2352x1568; 45-degree field of view; retinal fundus photograph.
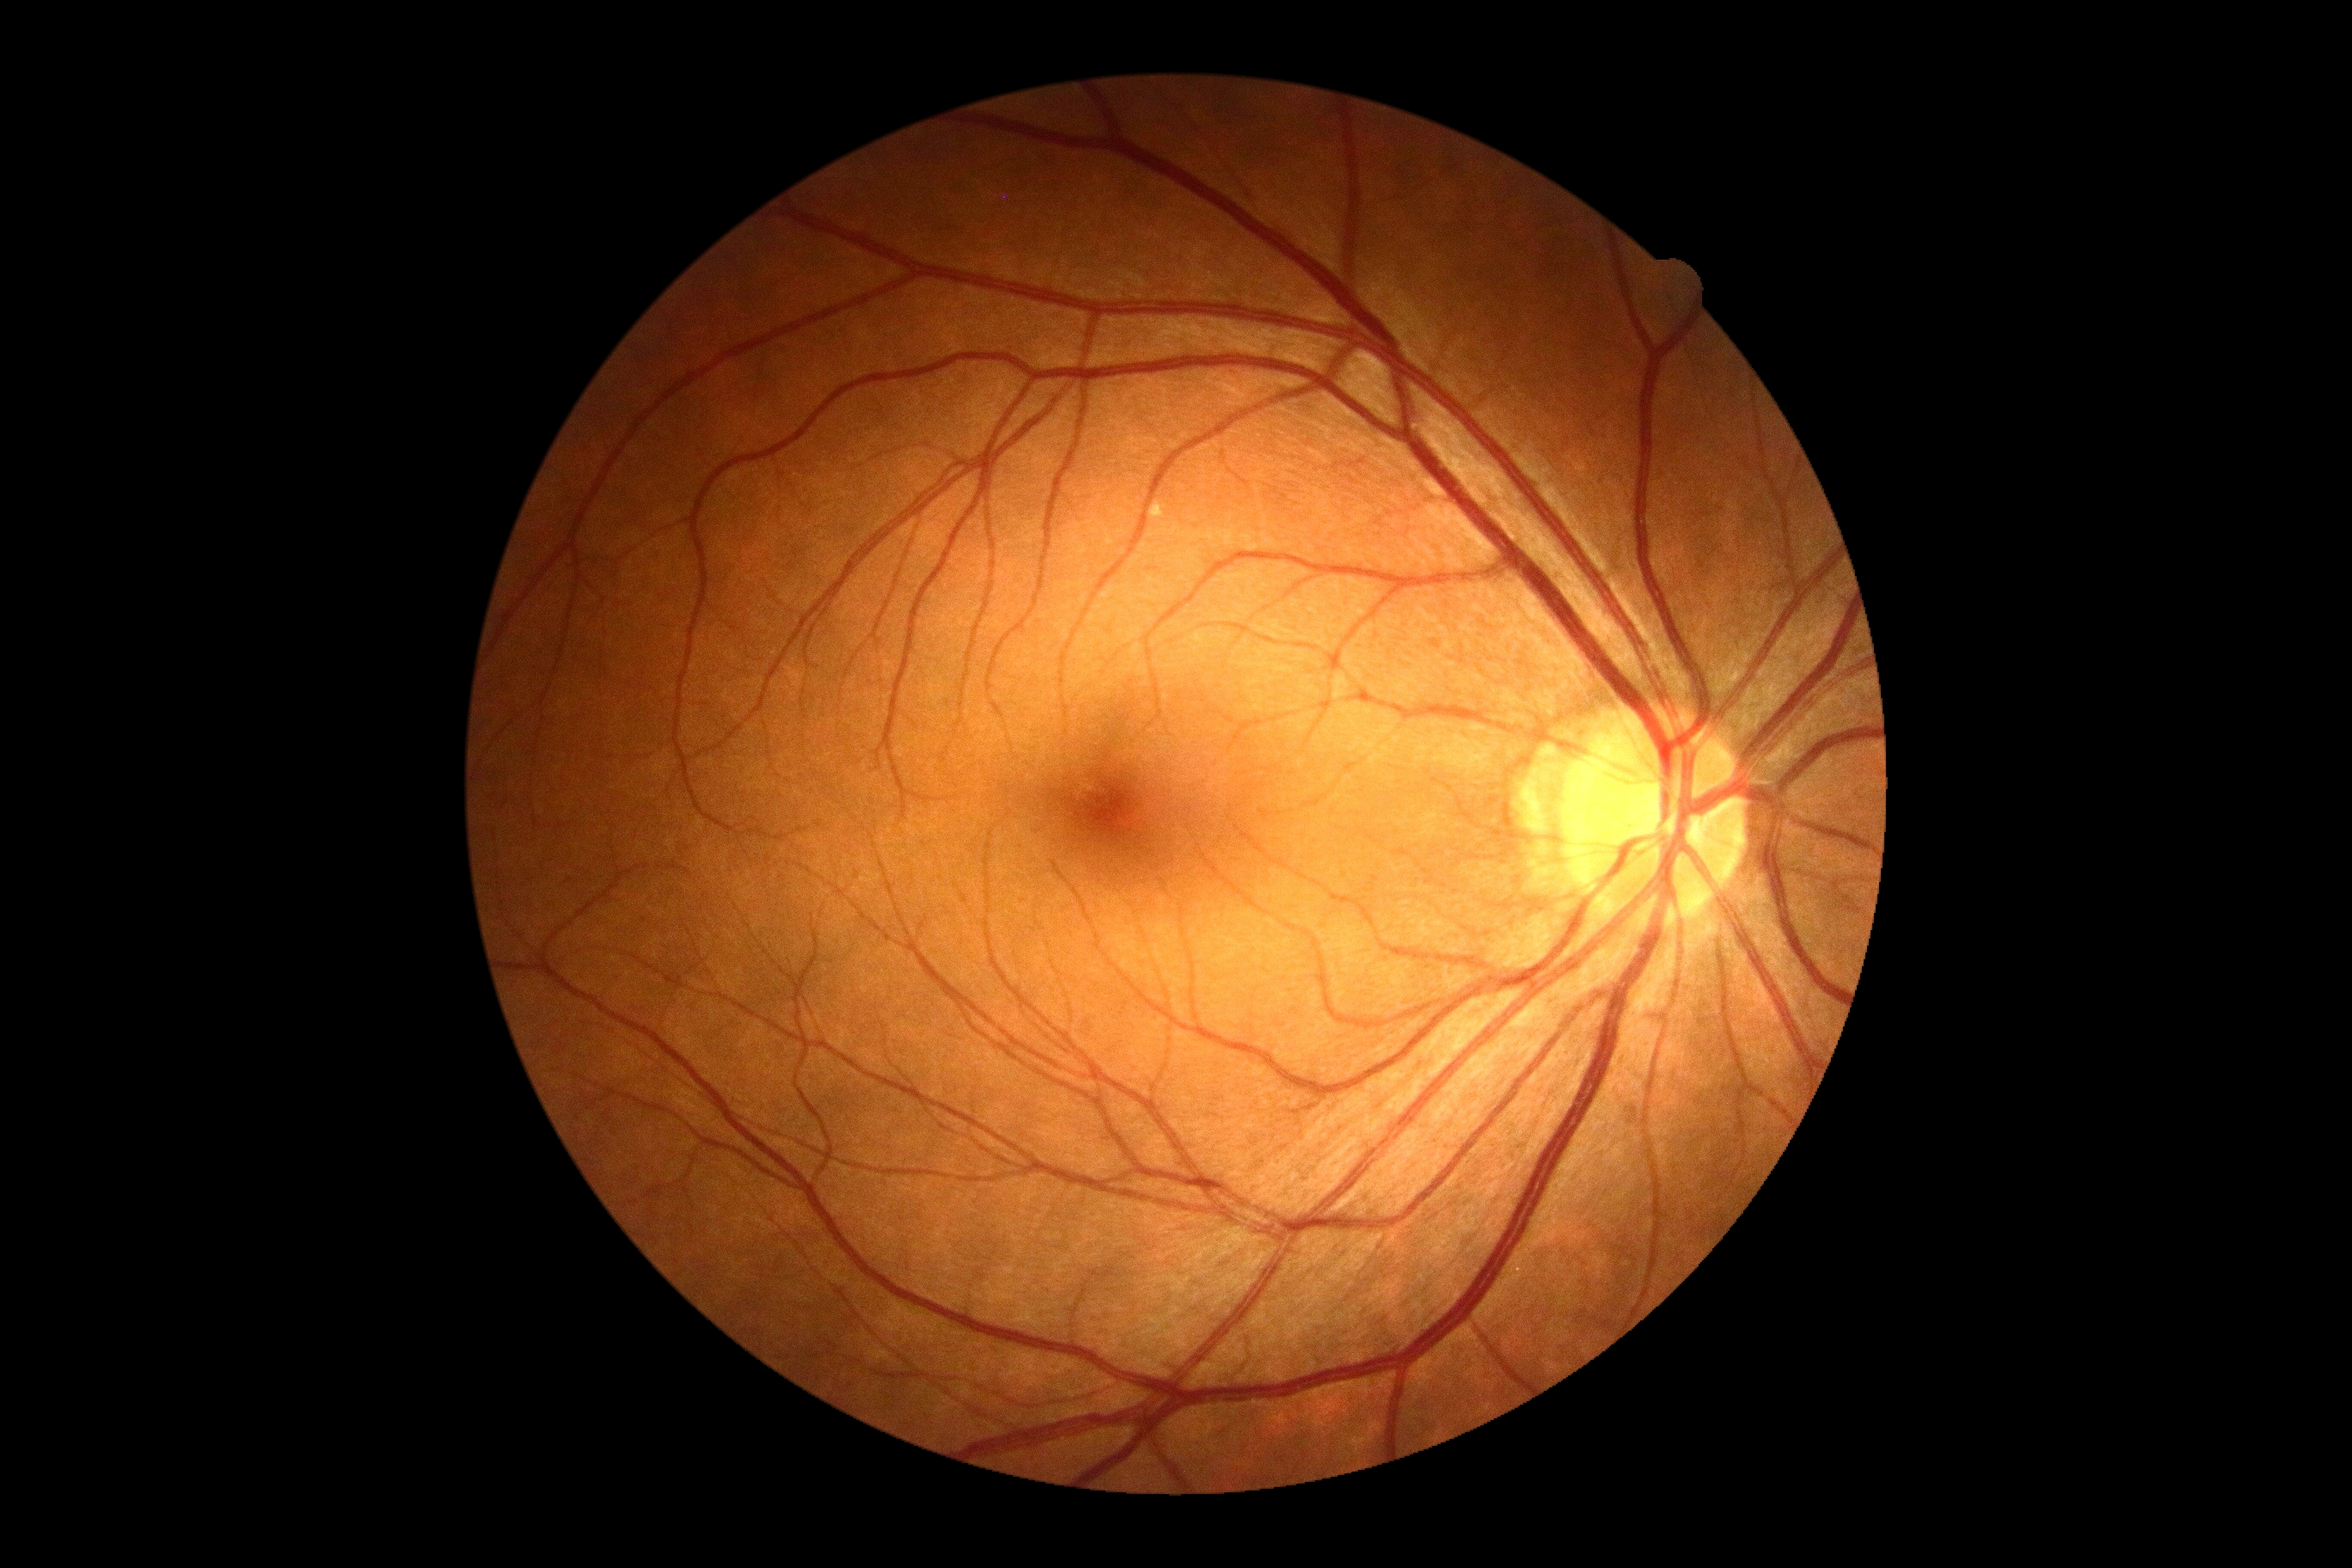
Diabetic retinopathy (DR): no apparent retinopathy (grade 0).
No DR findings.